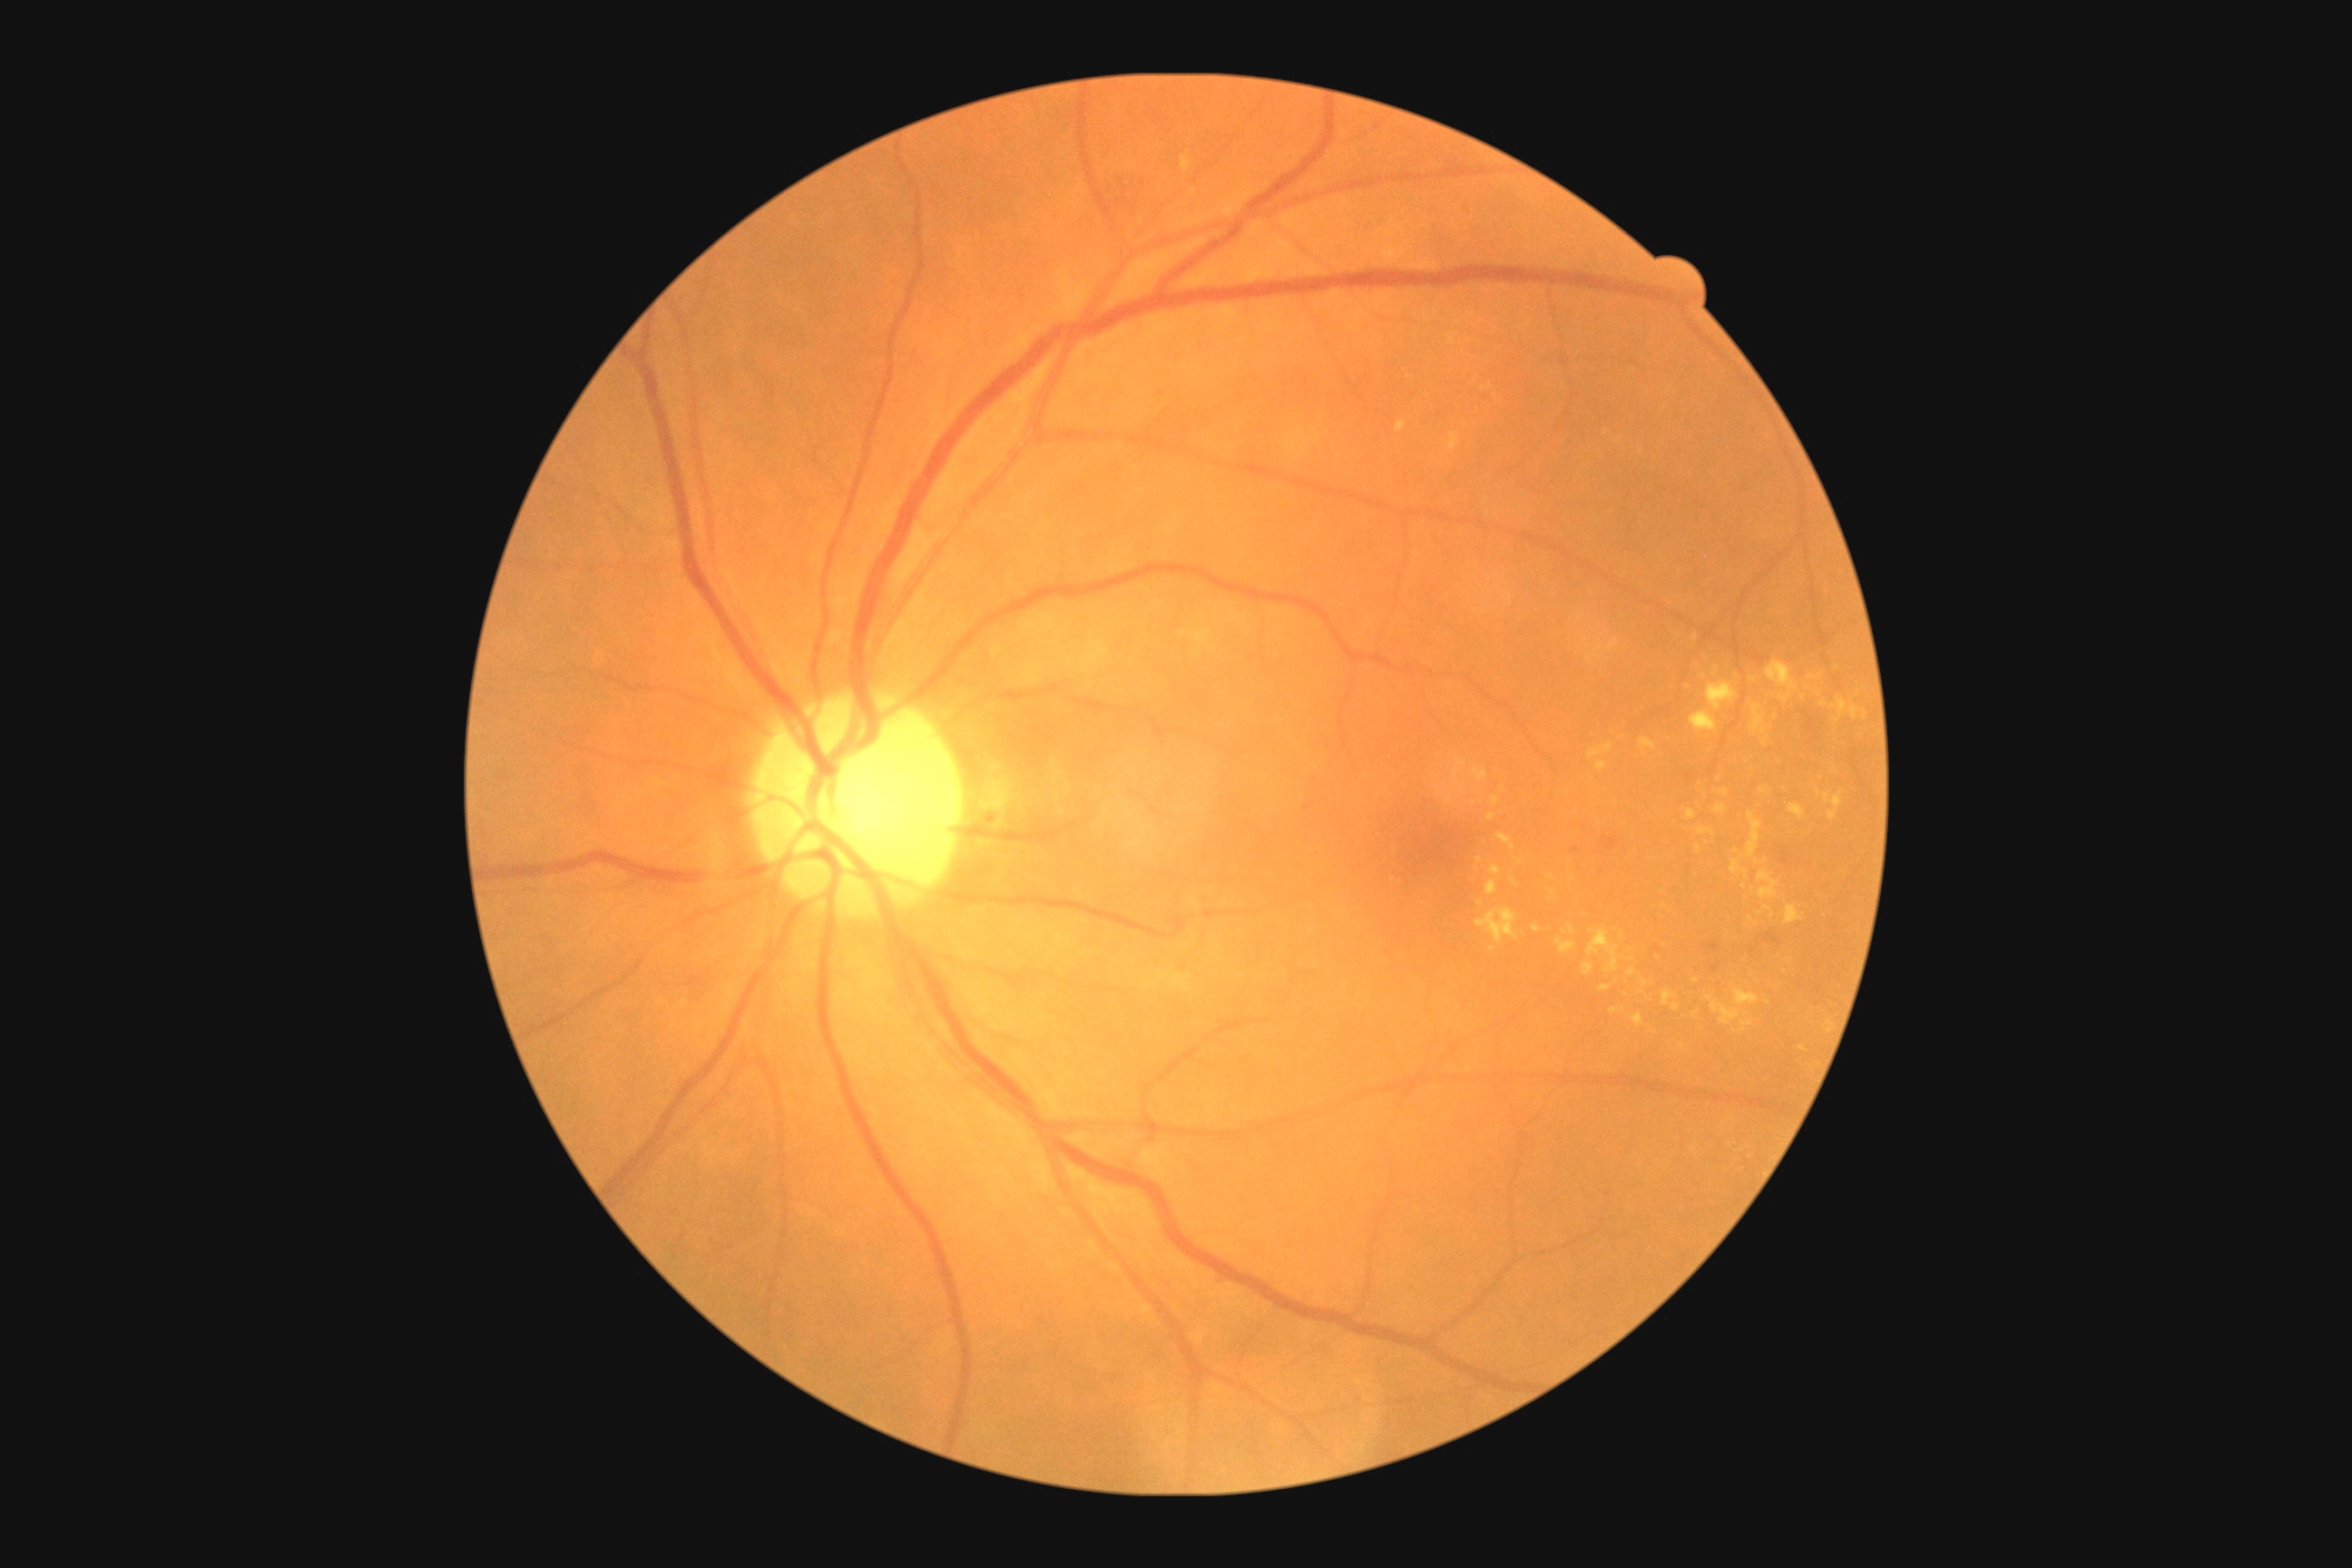 {
  "dr_category": "non-proliferative diabetic retinopathy",
  "dr_grade": "2/4"
}